2352x1568px; 45-degree field of view
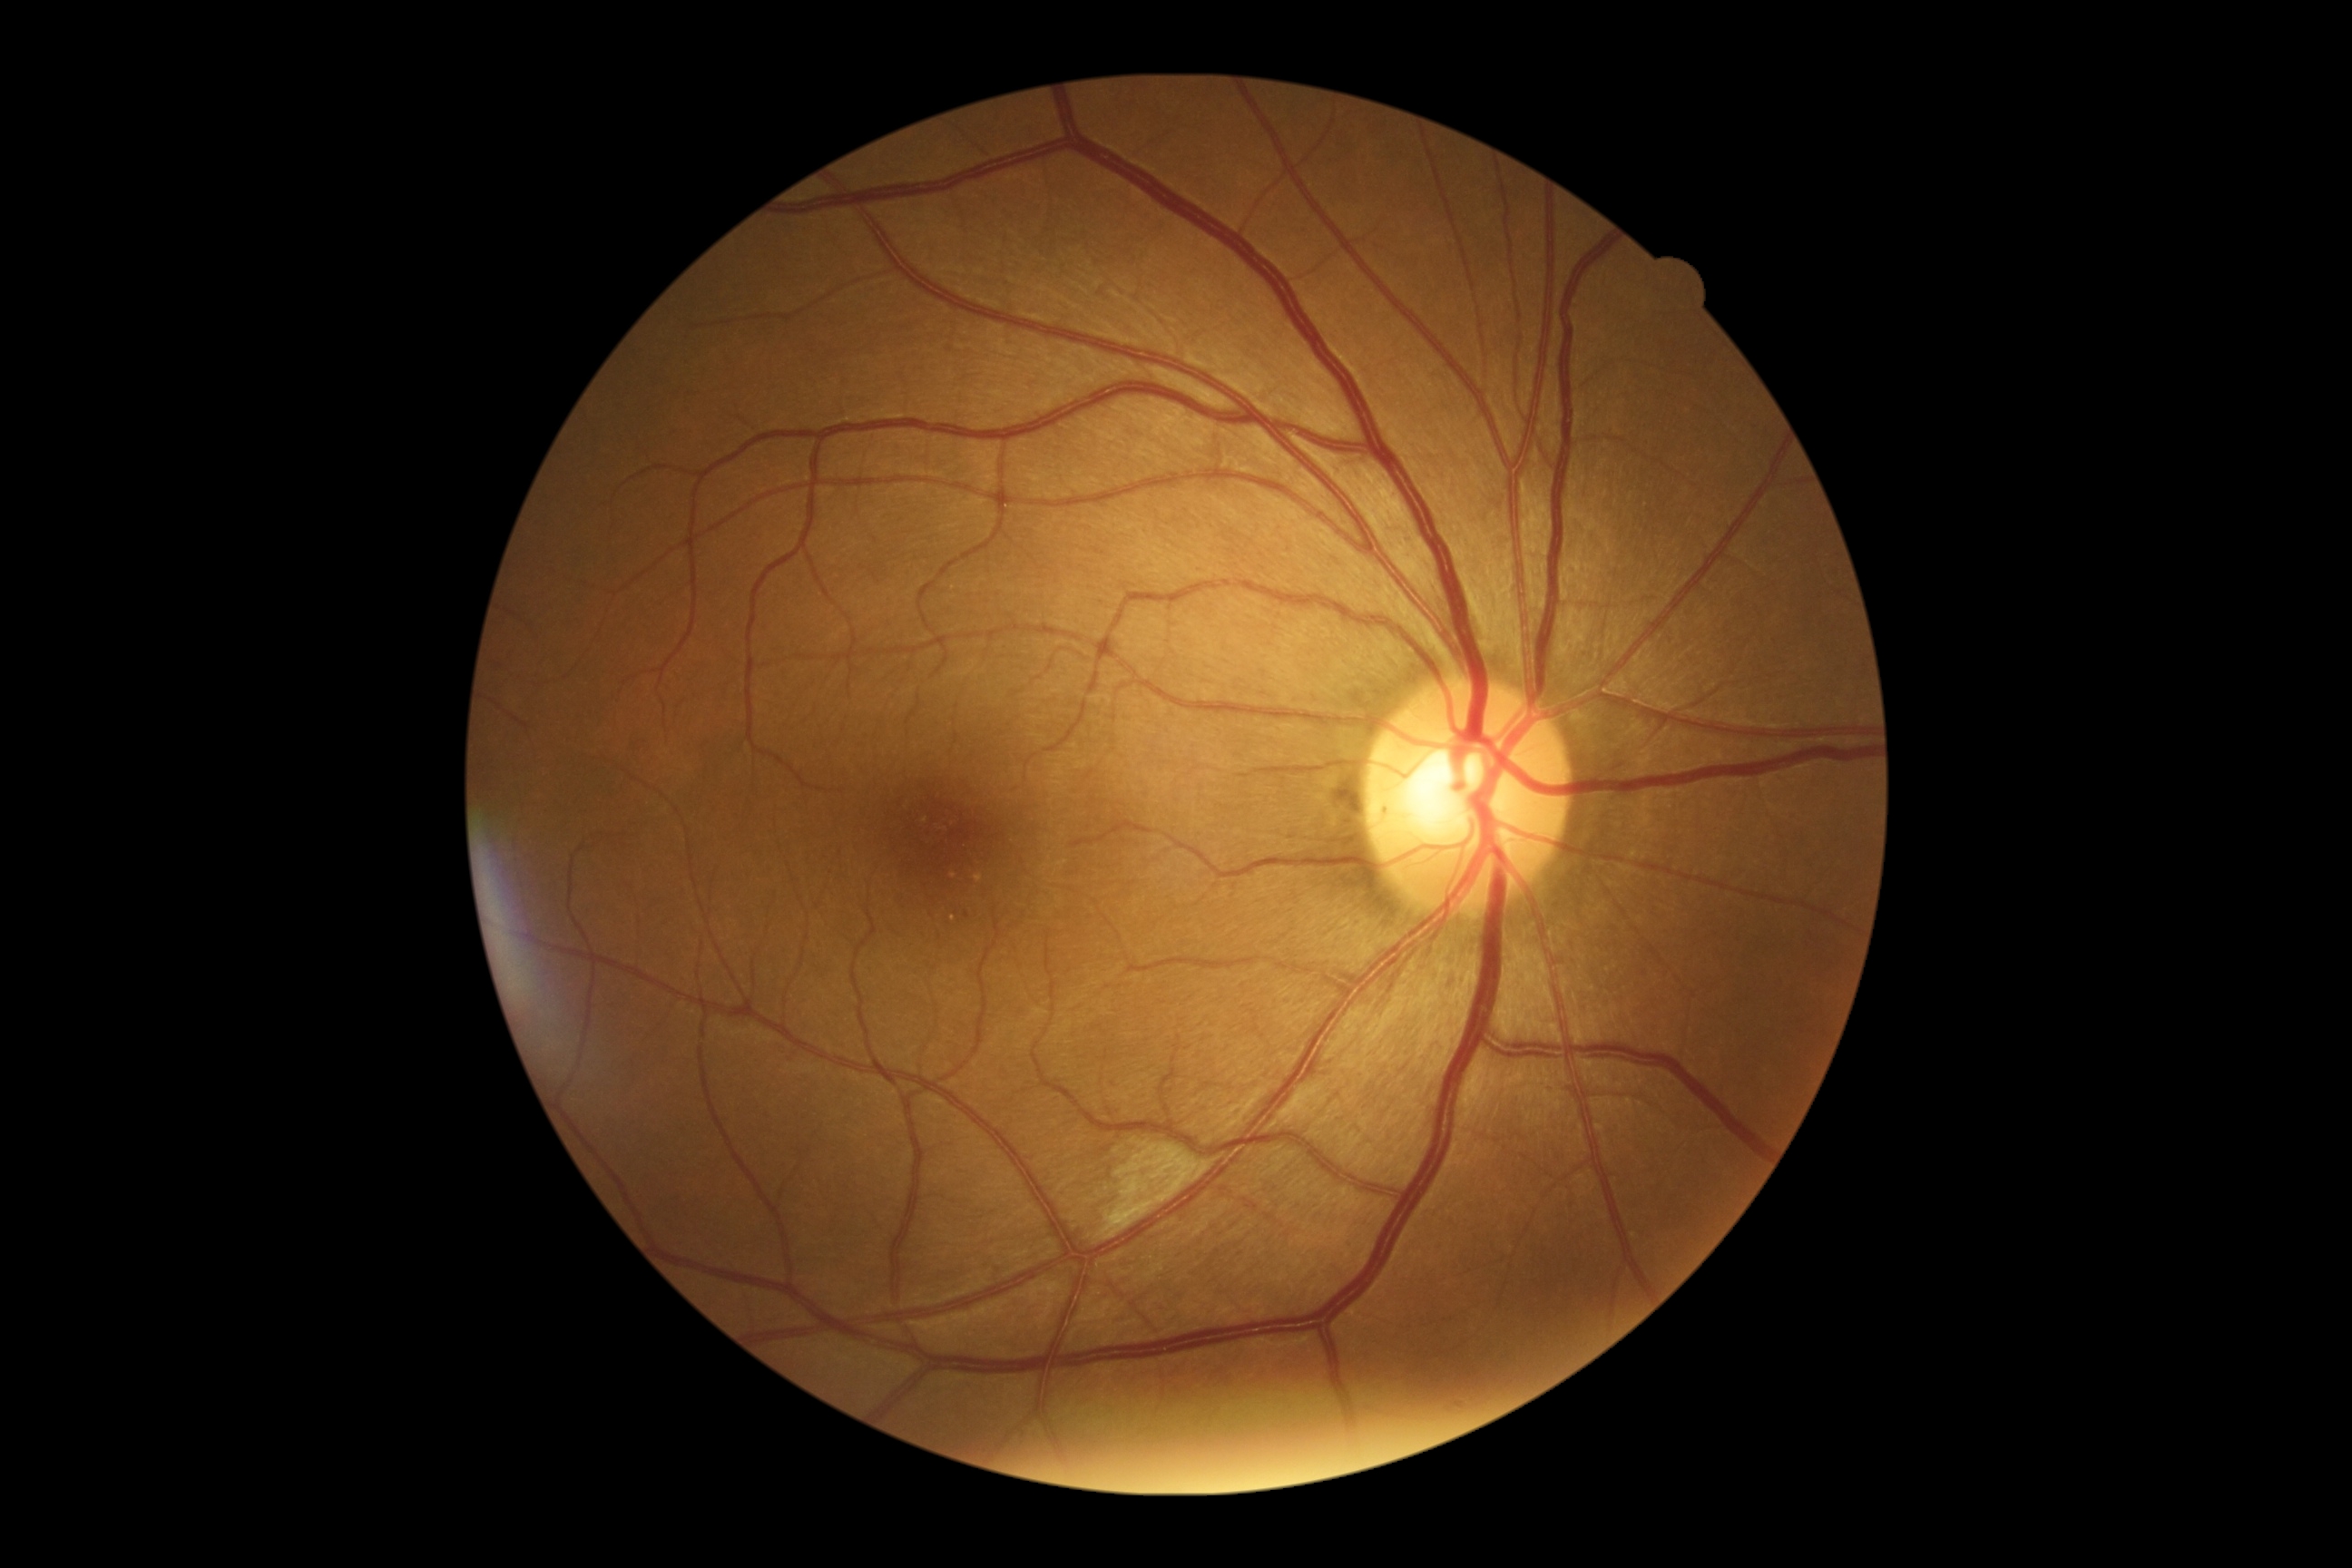
DR stage is moderate non-proliferative diabetic retinopathy (grade 2).